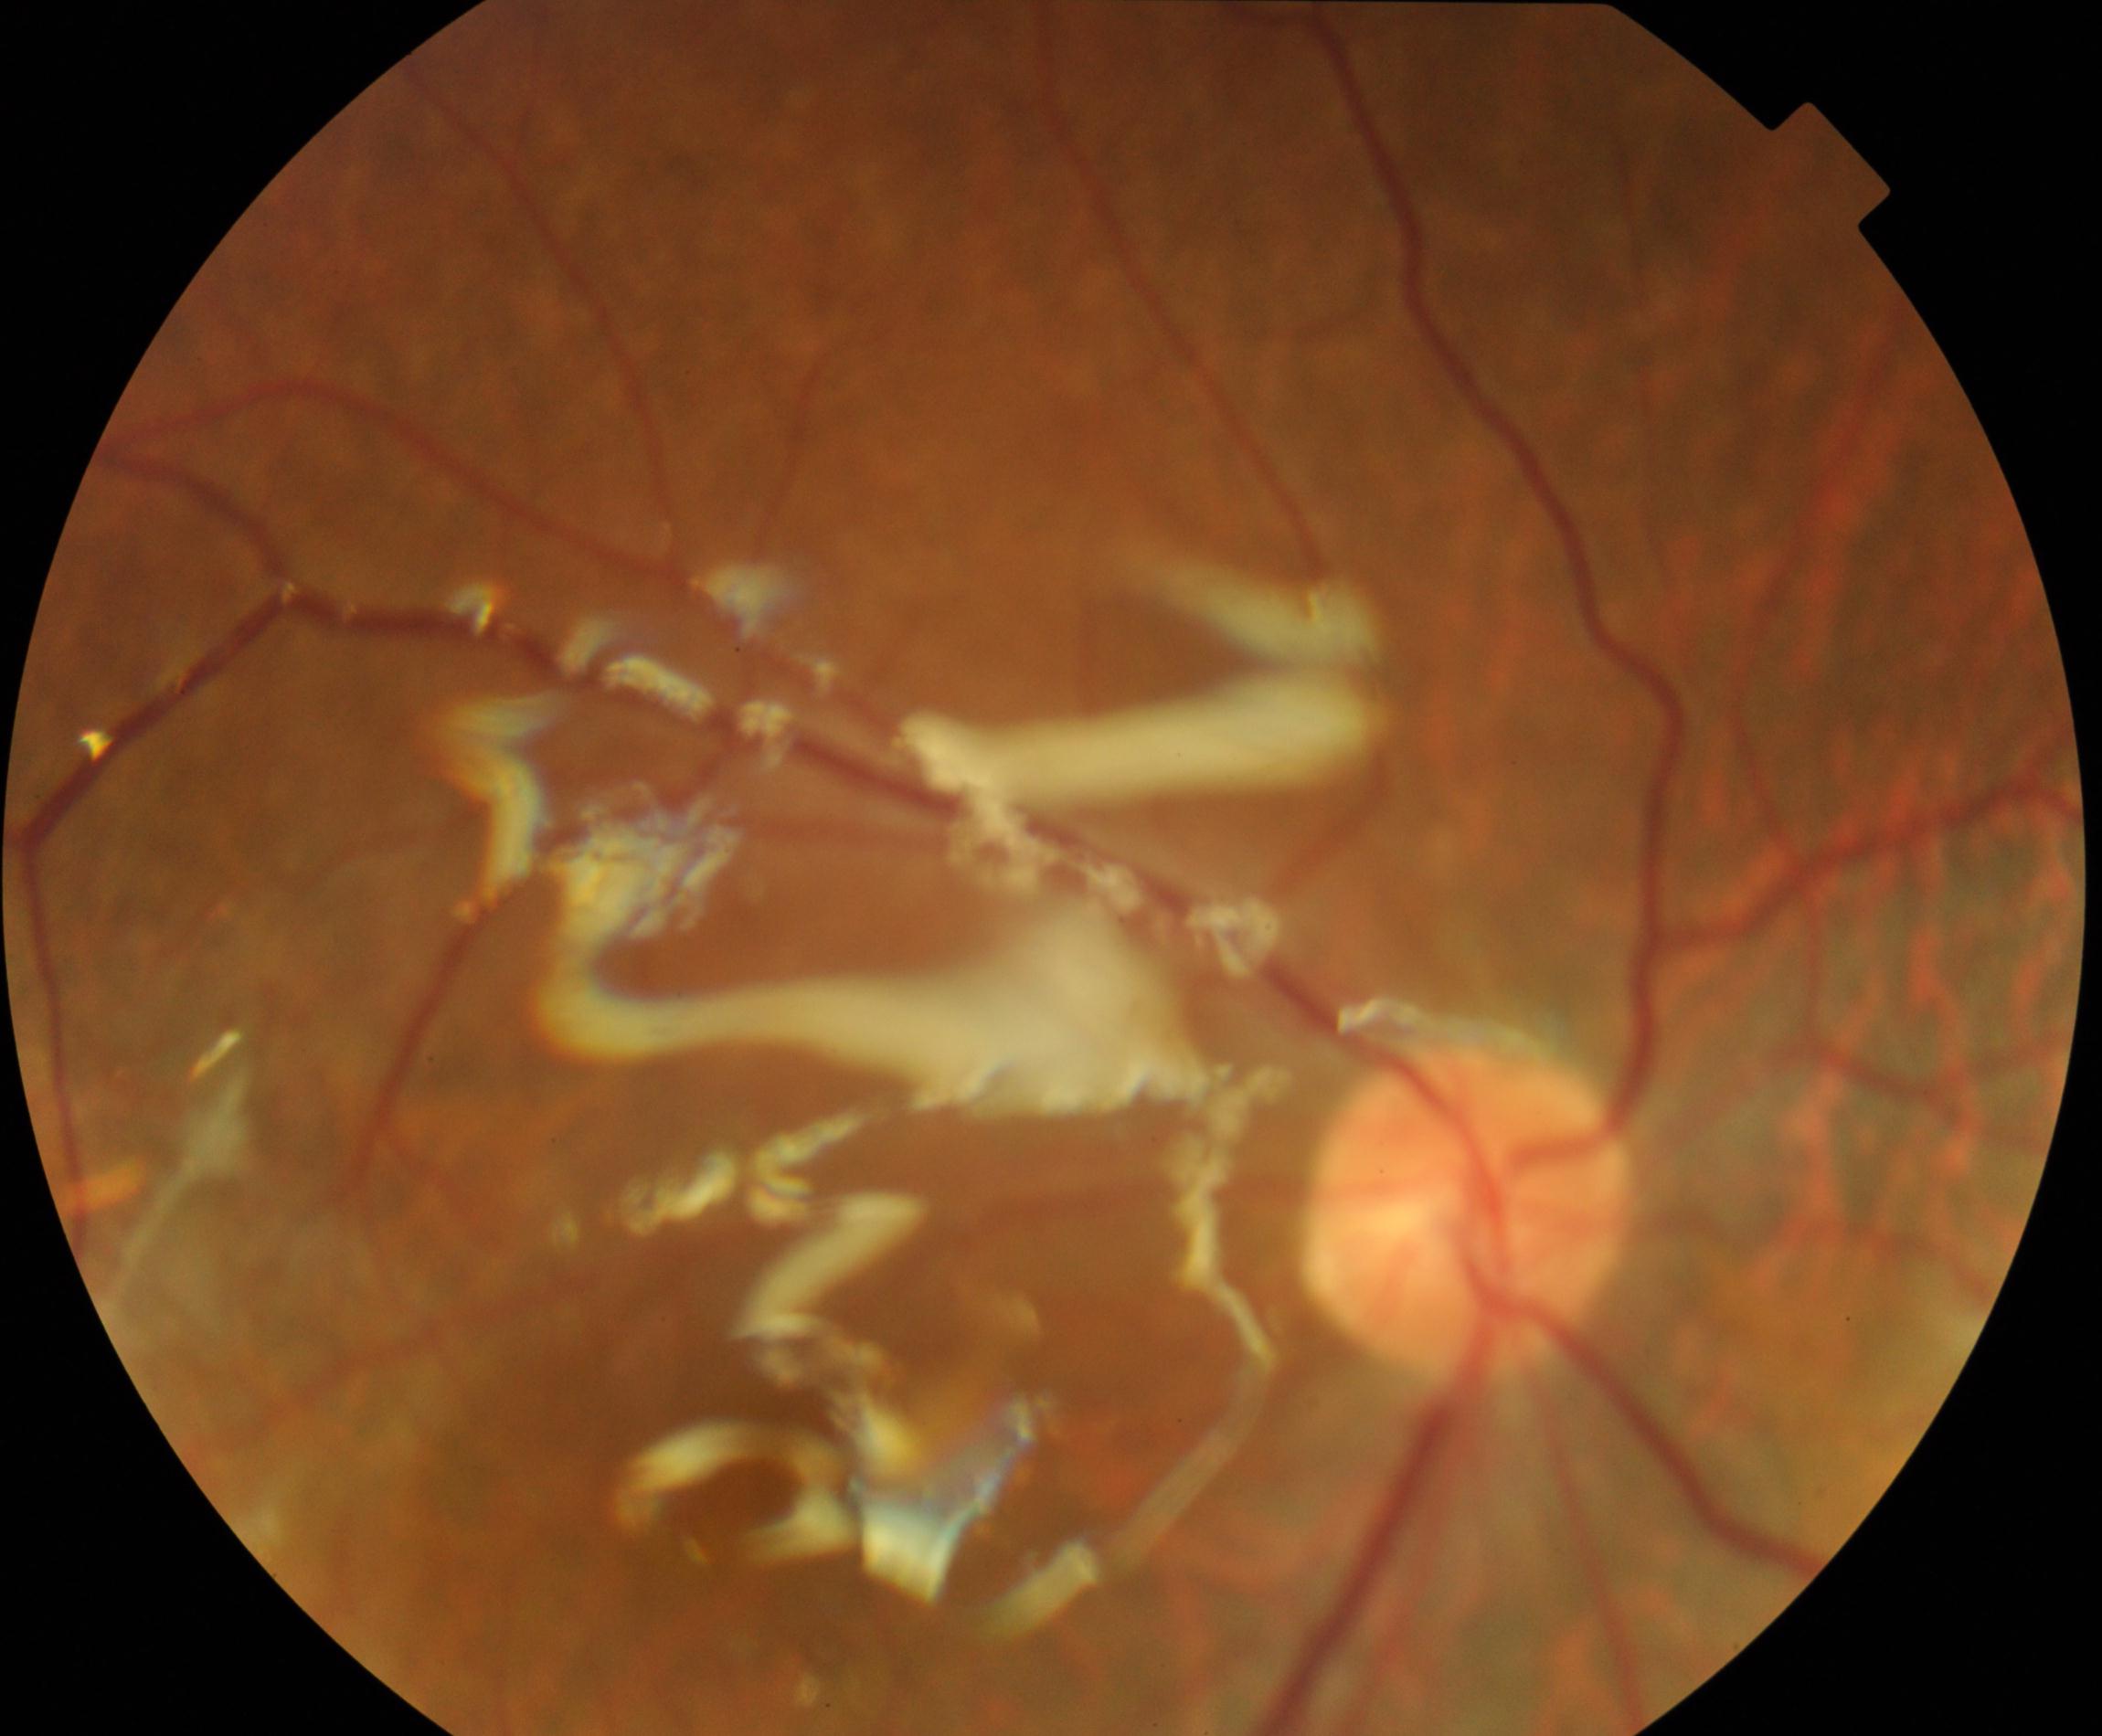 Findings: silicone oil in the eye.